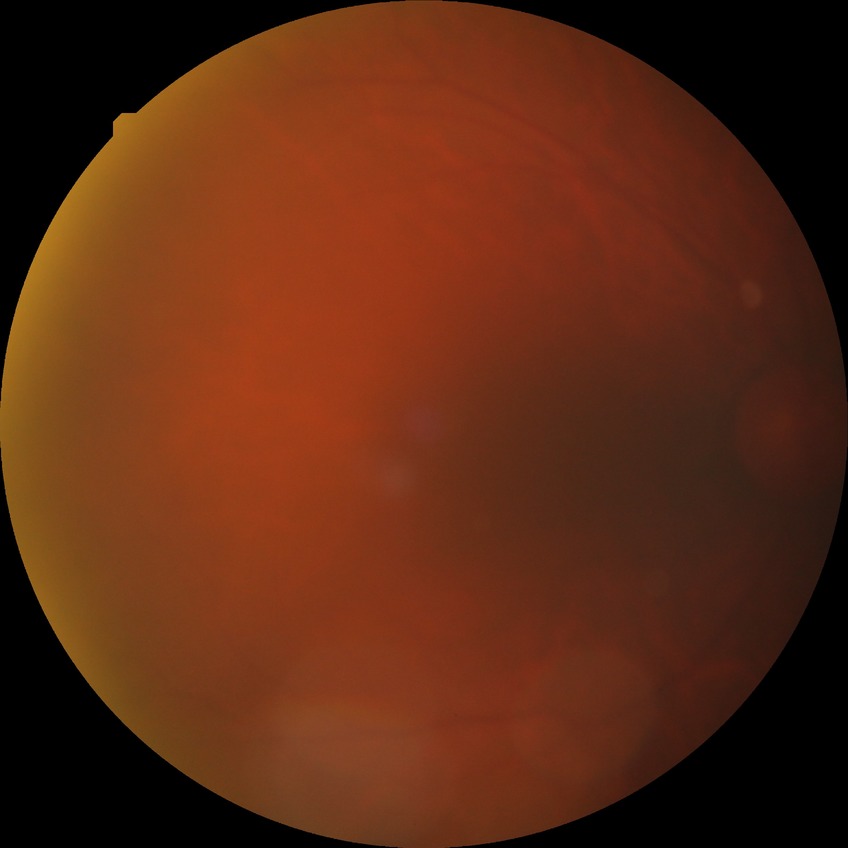

Modified Davis grading: no diabetic retinopathy.